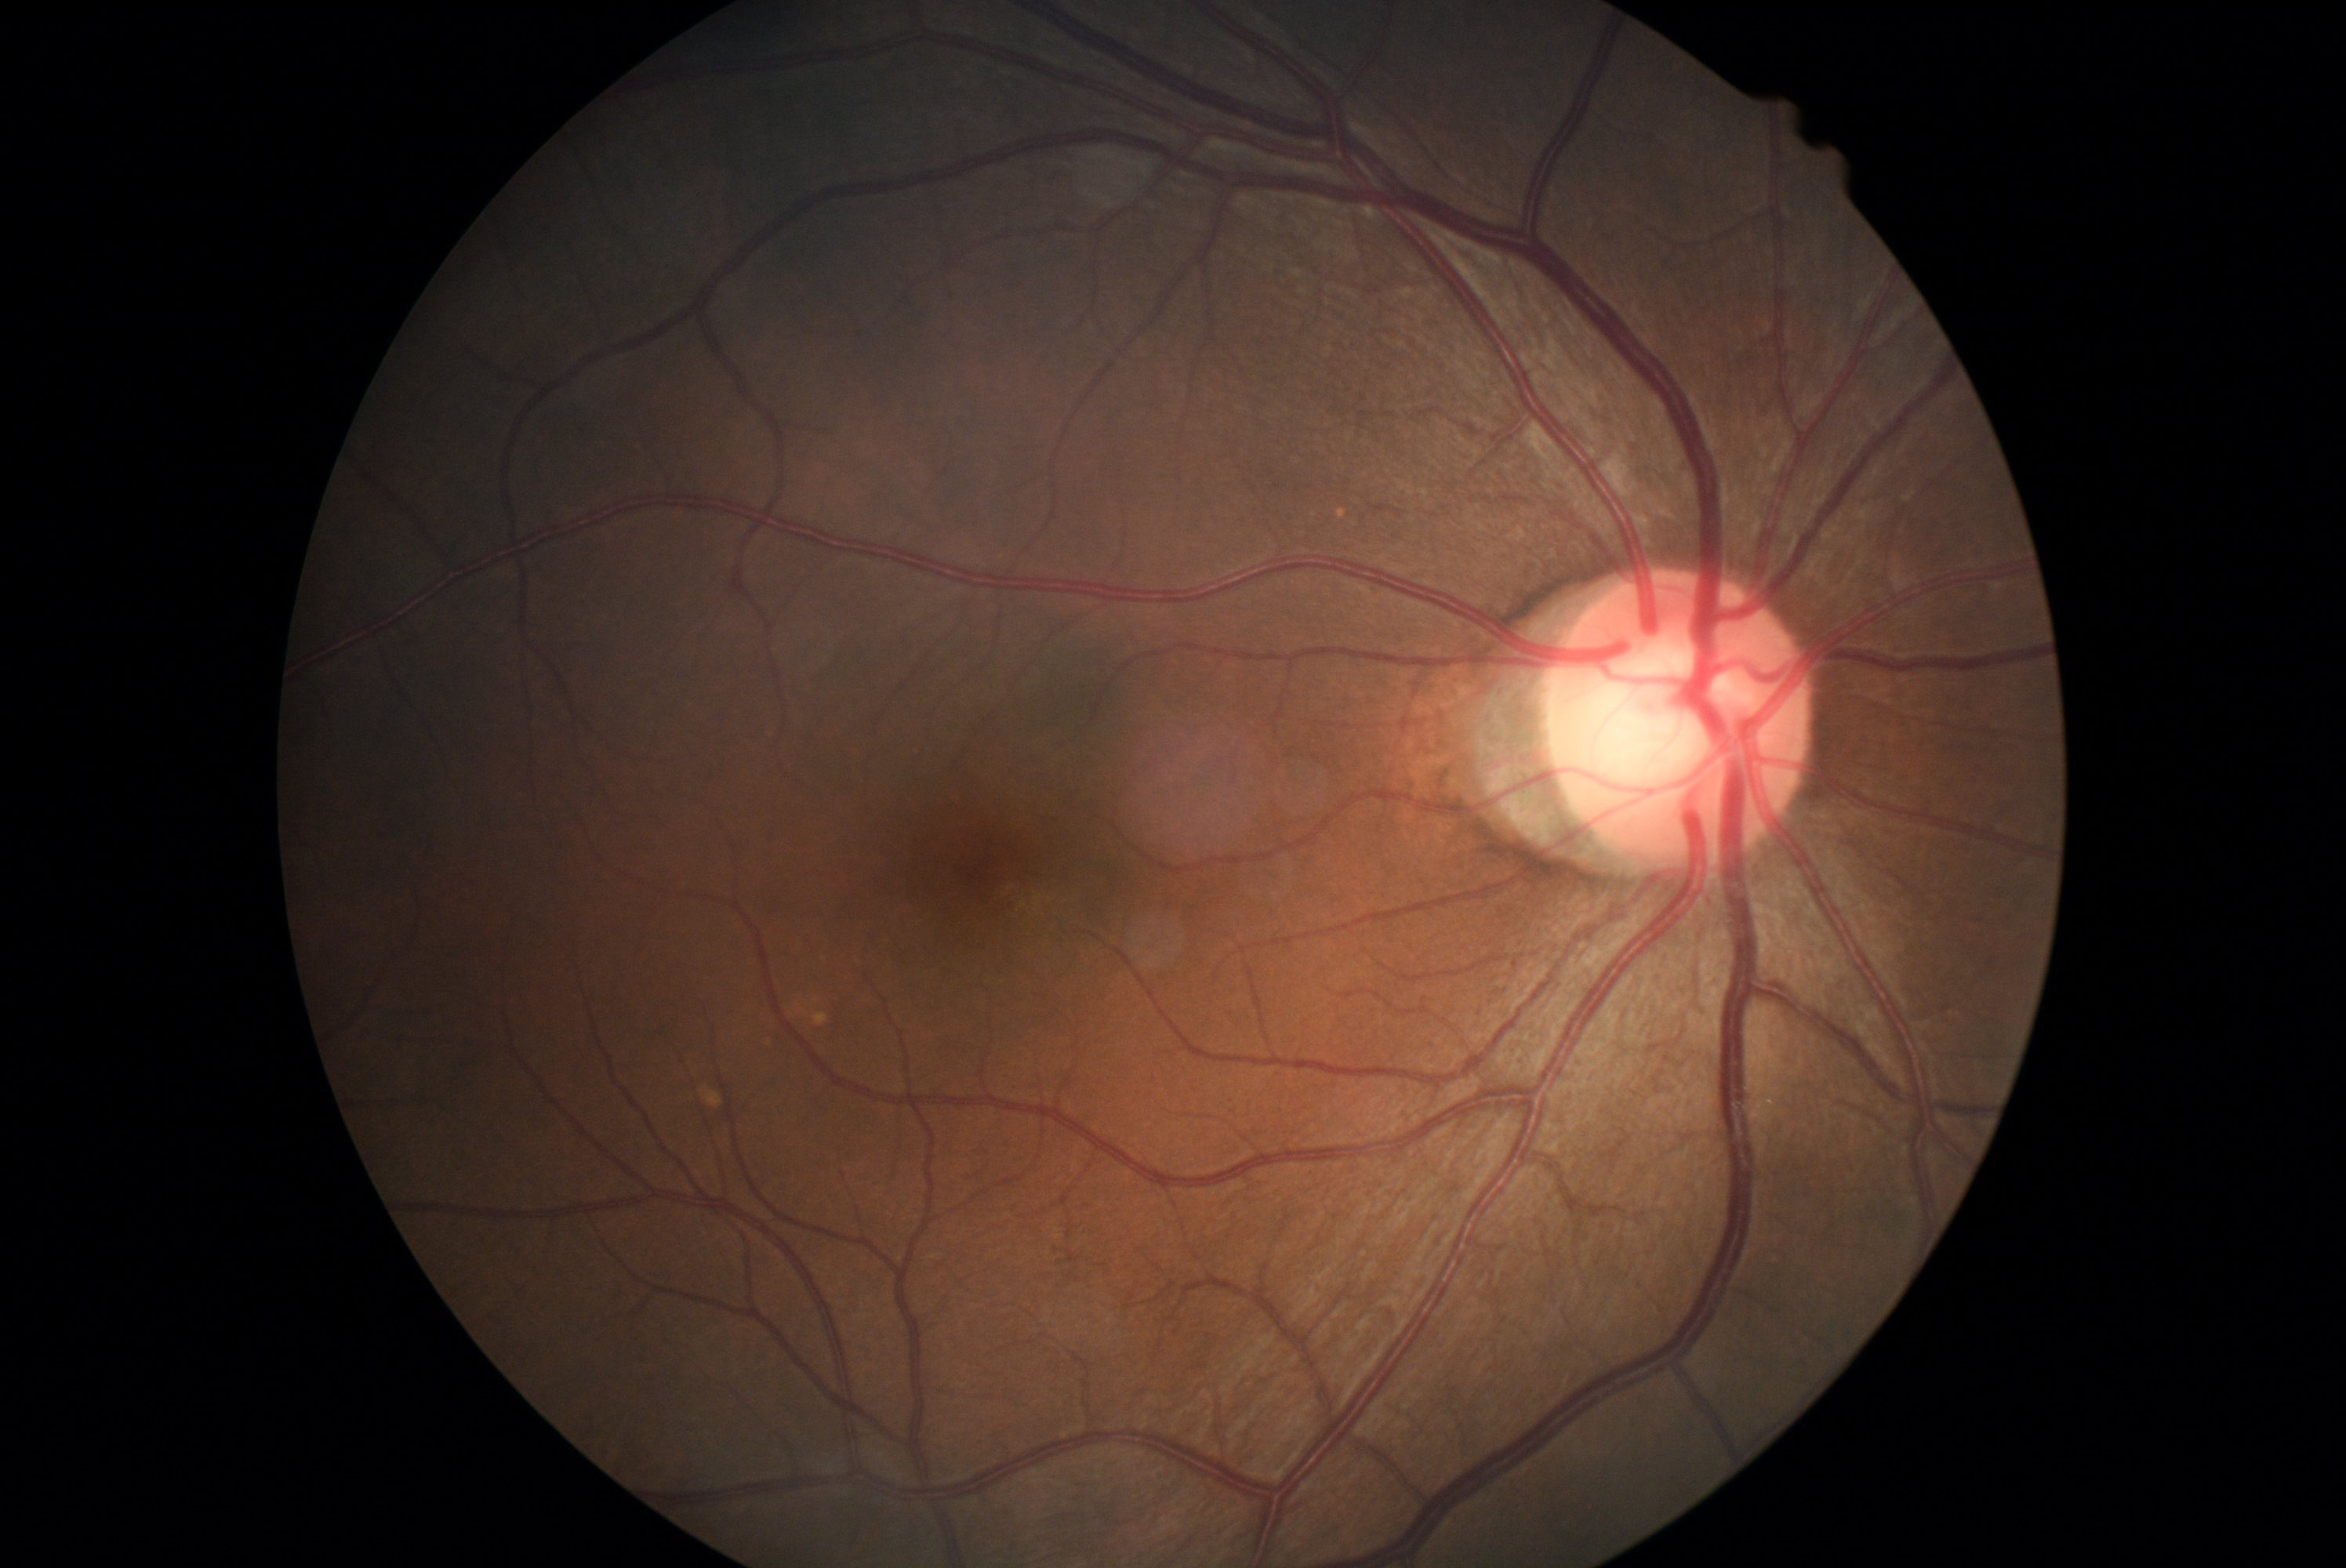 No DR findings. Diabetic retinopathy (DR): grade 0.